2212x1659px; fundus photo taken with a portable handheld camera; 60° FOV.
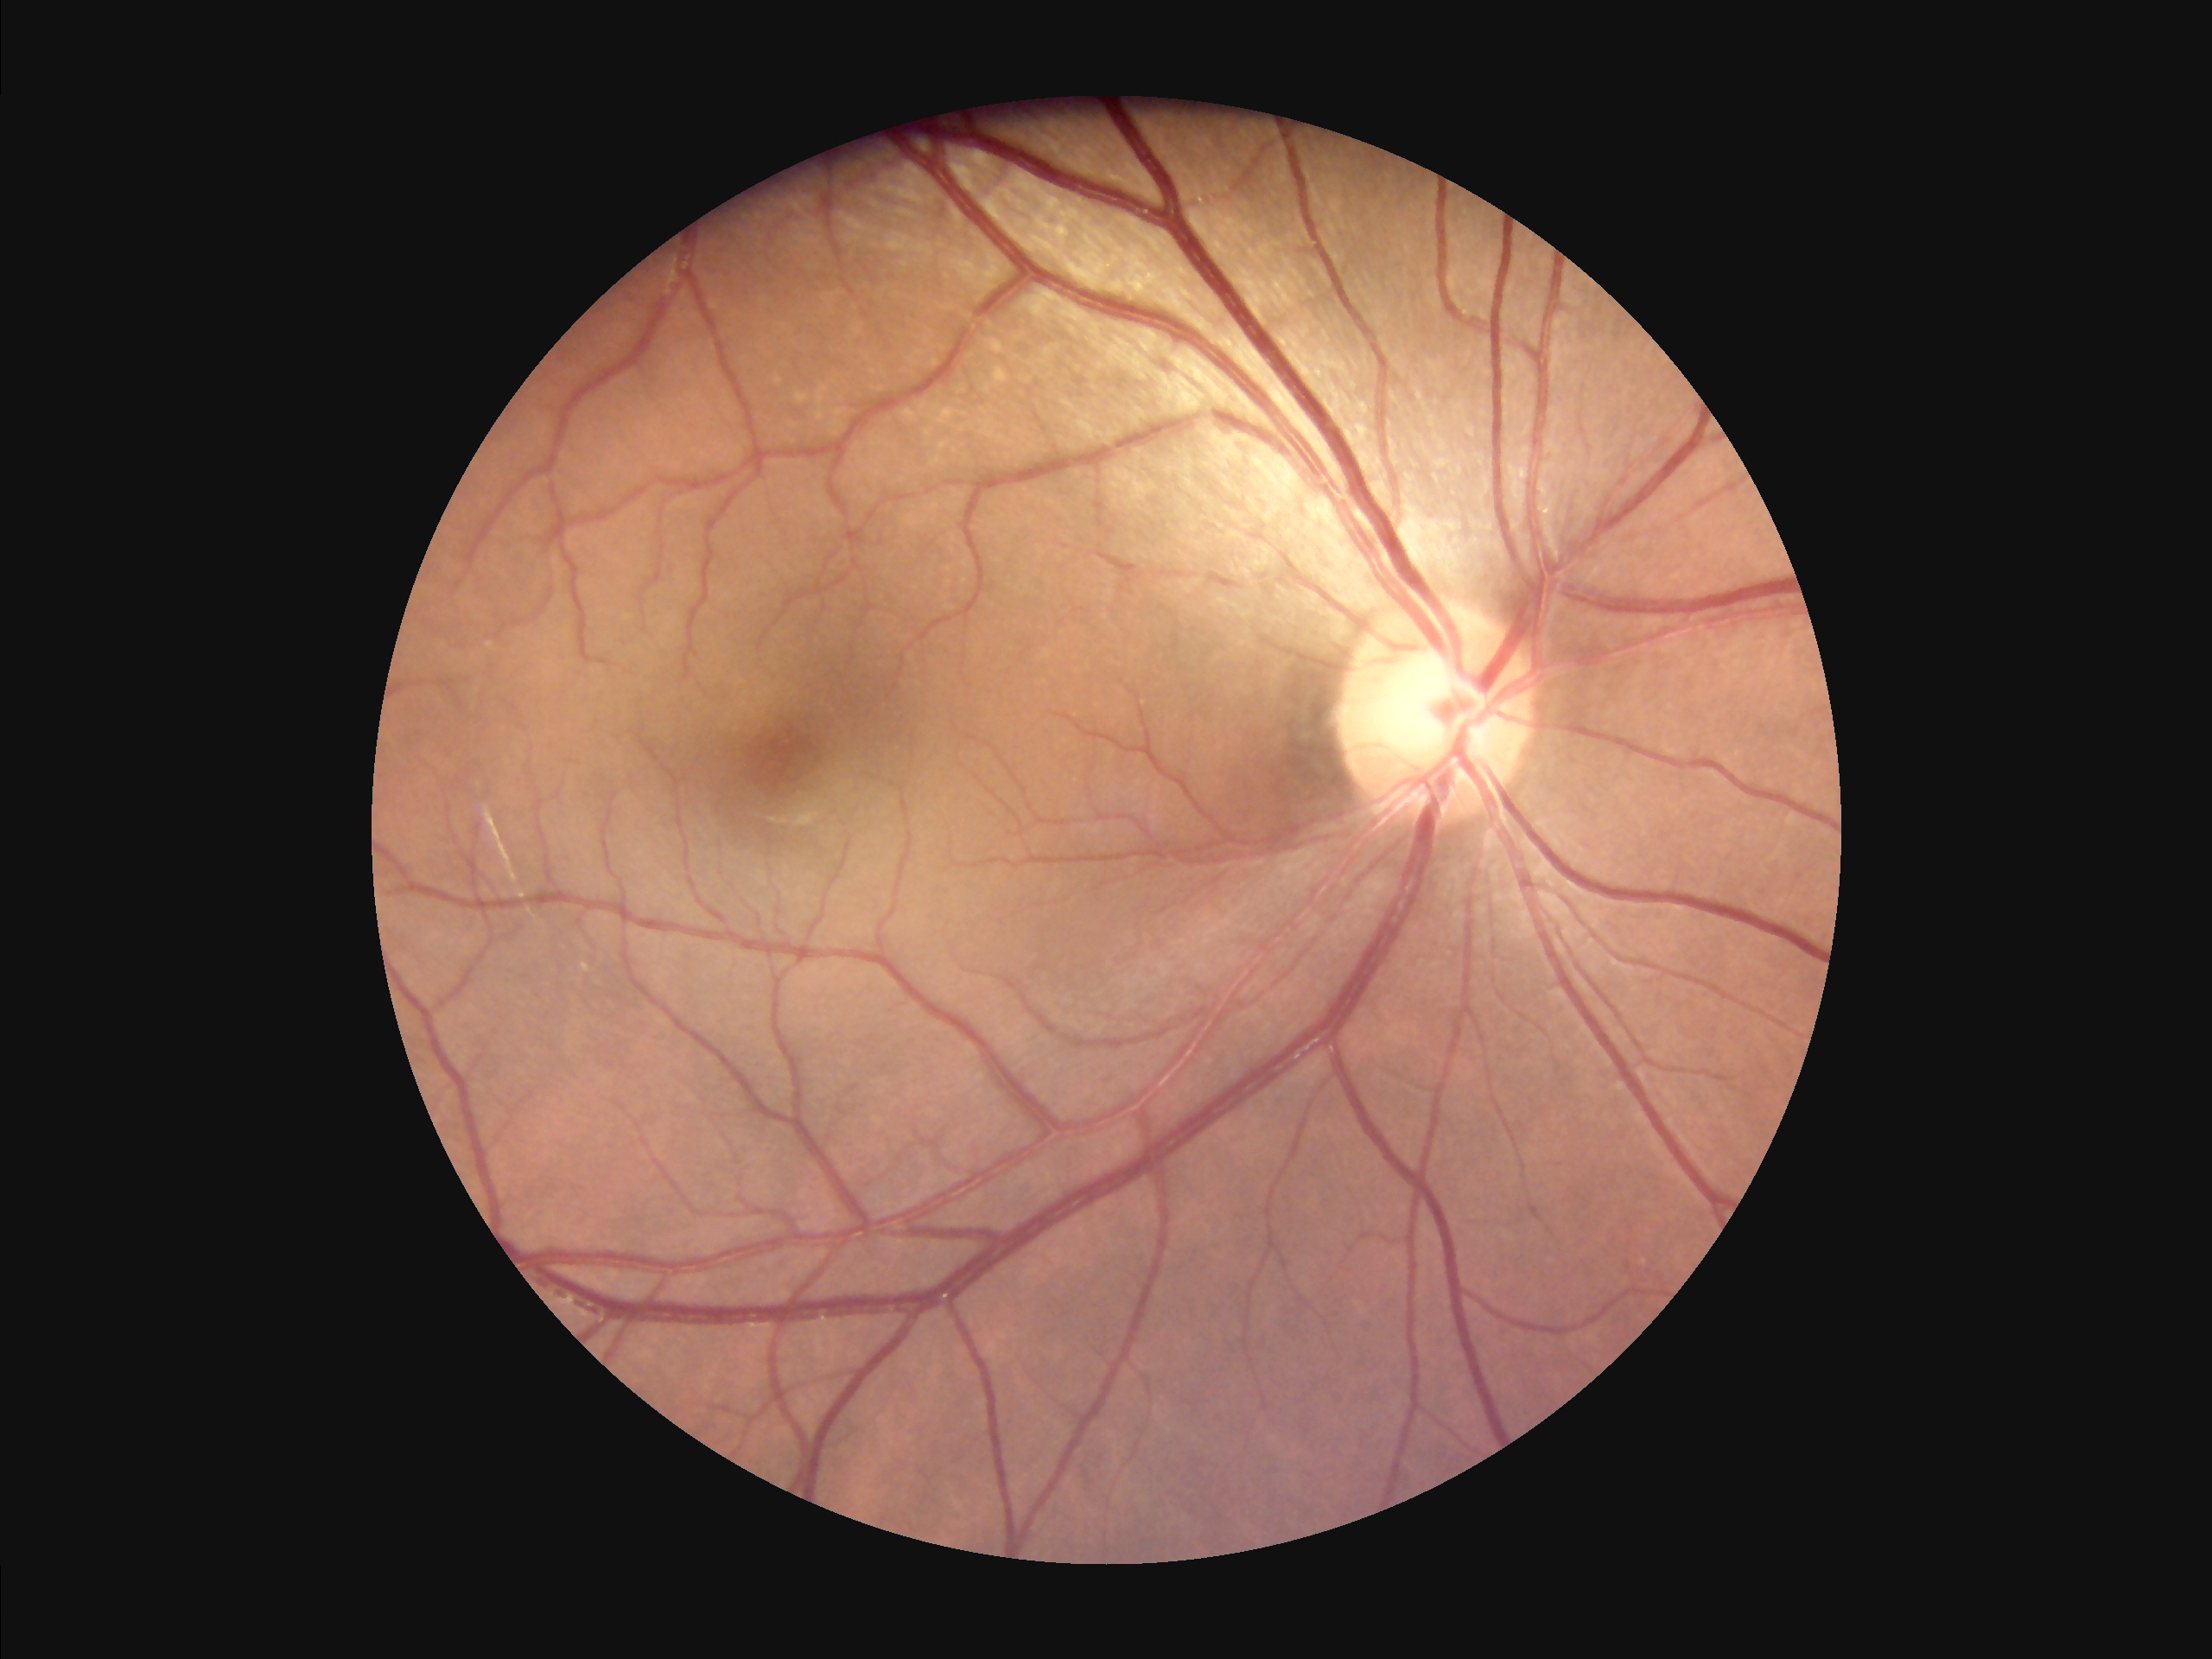
Even illumination with no color cast.
Overall quality is good and the image is gradable.
Adequate contrast for distinguishing structures.